Acquired on the Natus RetCam Envision · 1440 x 1080 pixels · wide-field contact fundus photograph of an infant:
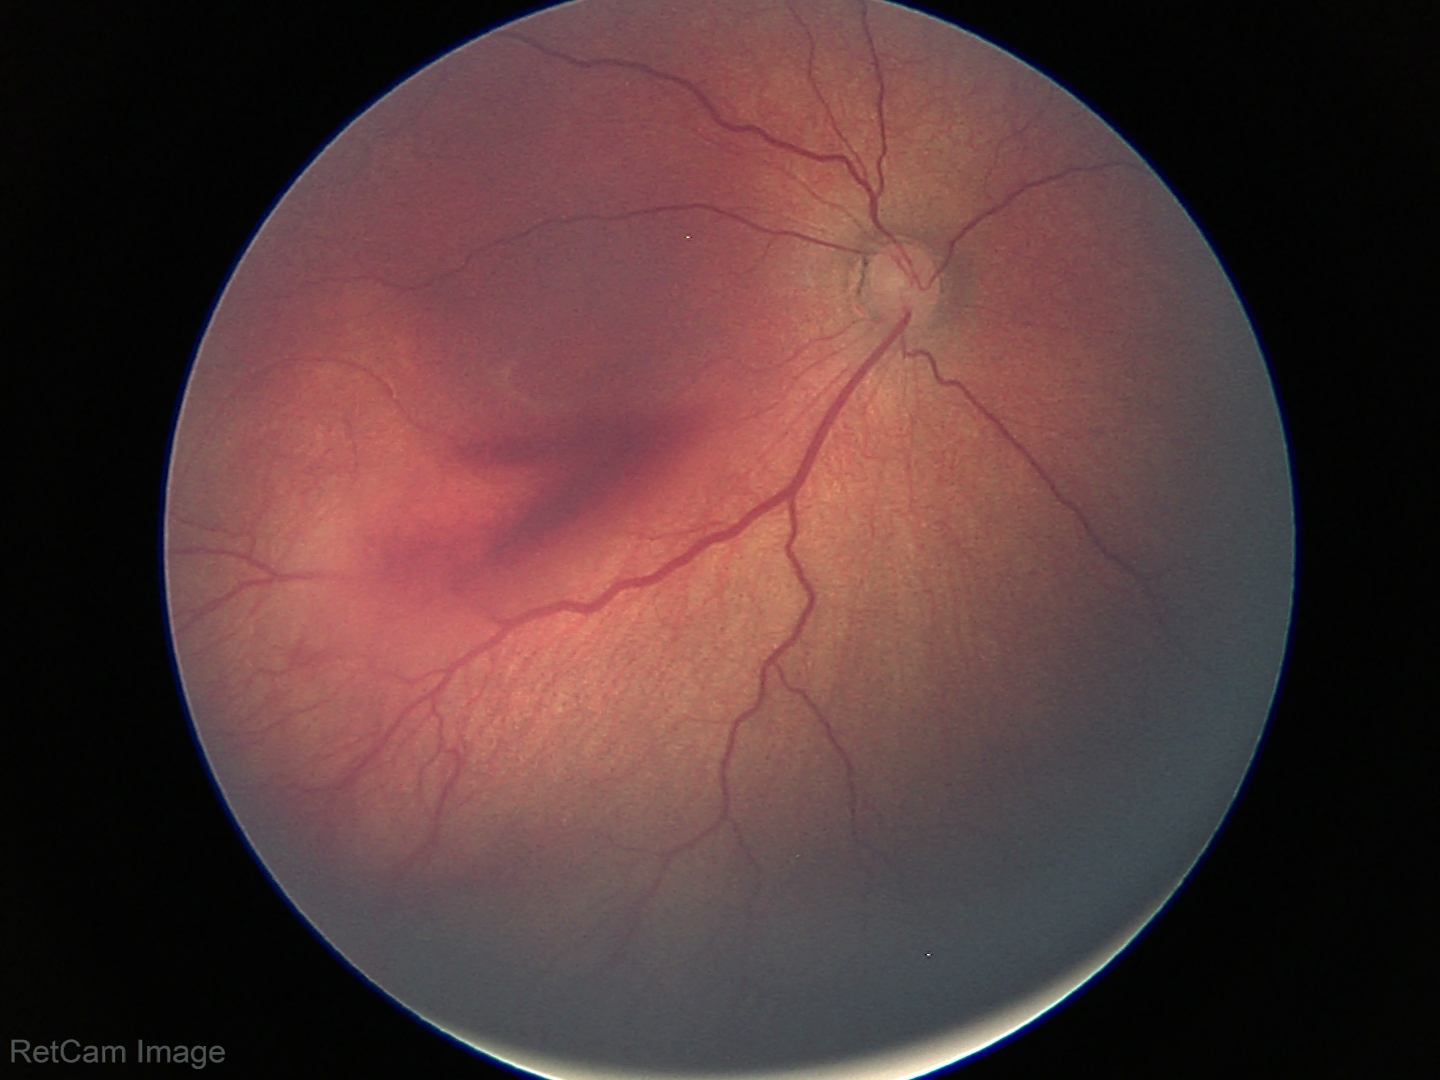

Screening series with retinopathy of prematurity (ROP) stage 3.